Image size 640x480. Infant wide-field fundus photograph
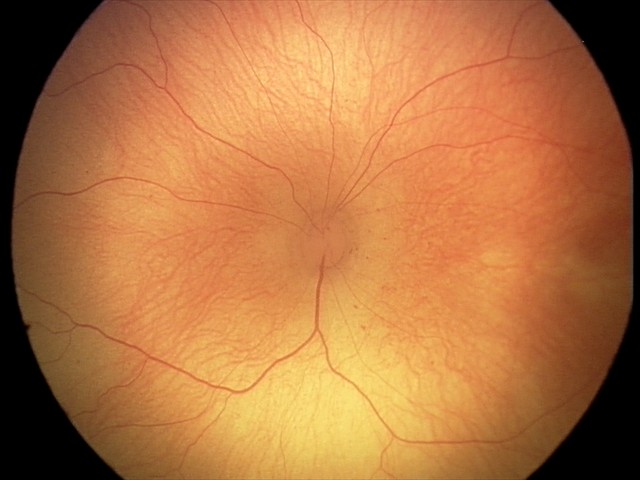
ROP stage: 1.